1240x1240; camera: Phoenix ICON (100° FOV); wide-field fundus photograph of an infant:
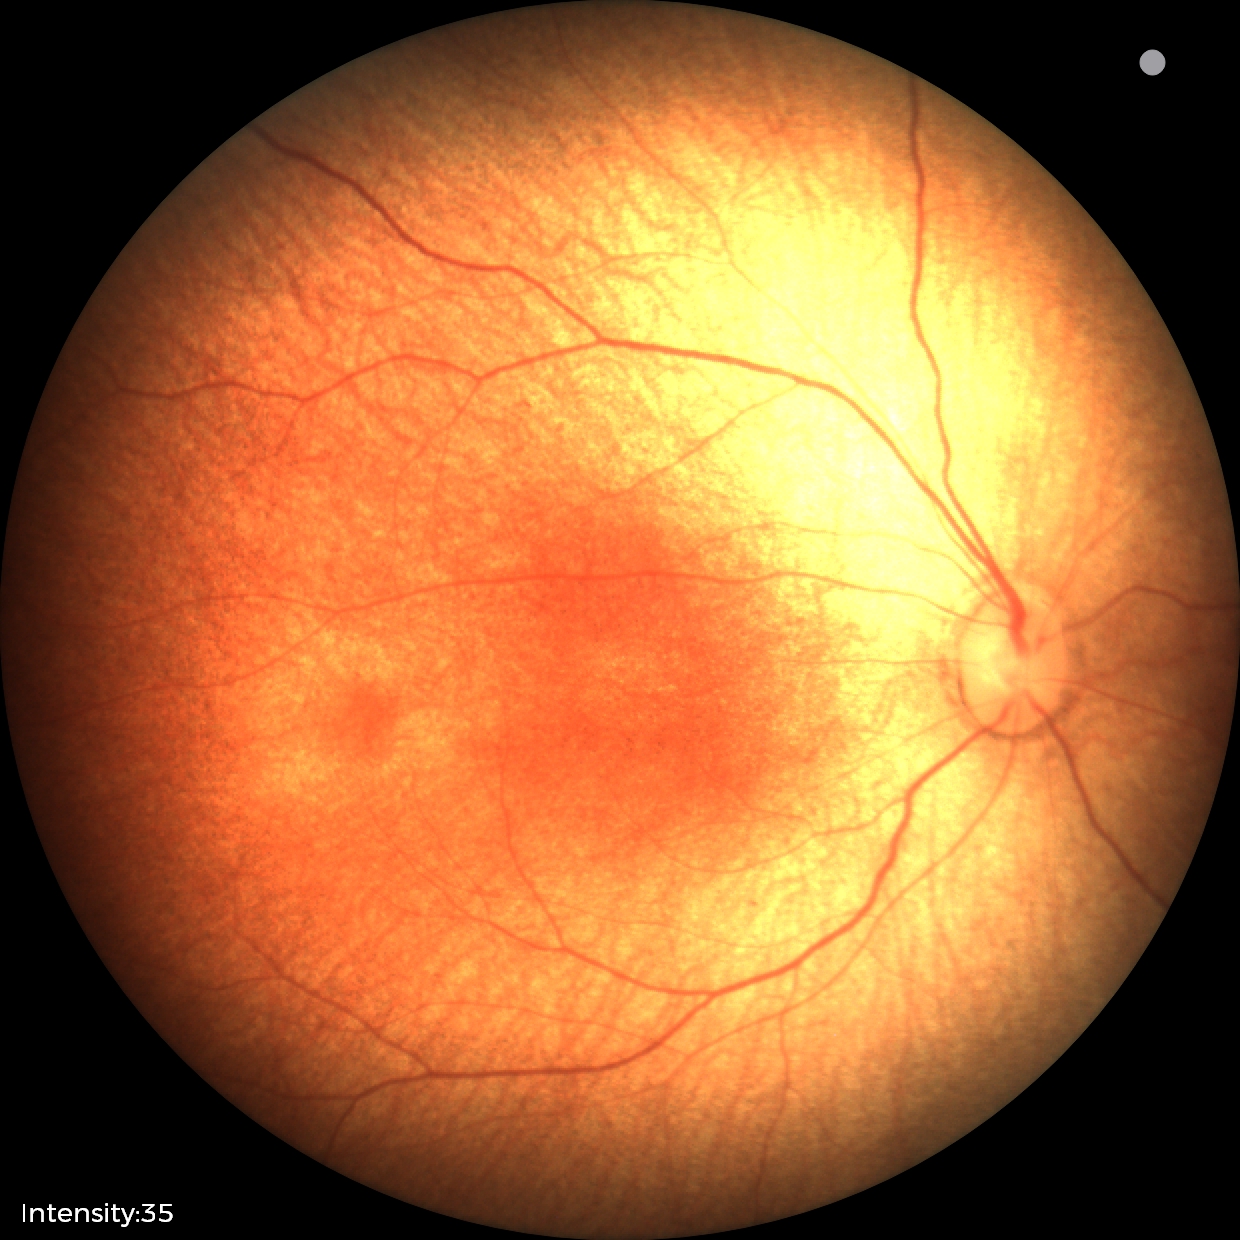 Physiological retinal appearance for postconceptual age.